Wide-field fundus photograph of an infant. Phoenix ICON, 100° FOV — 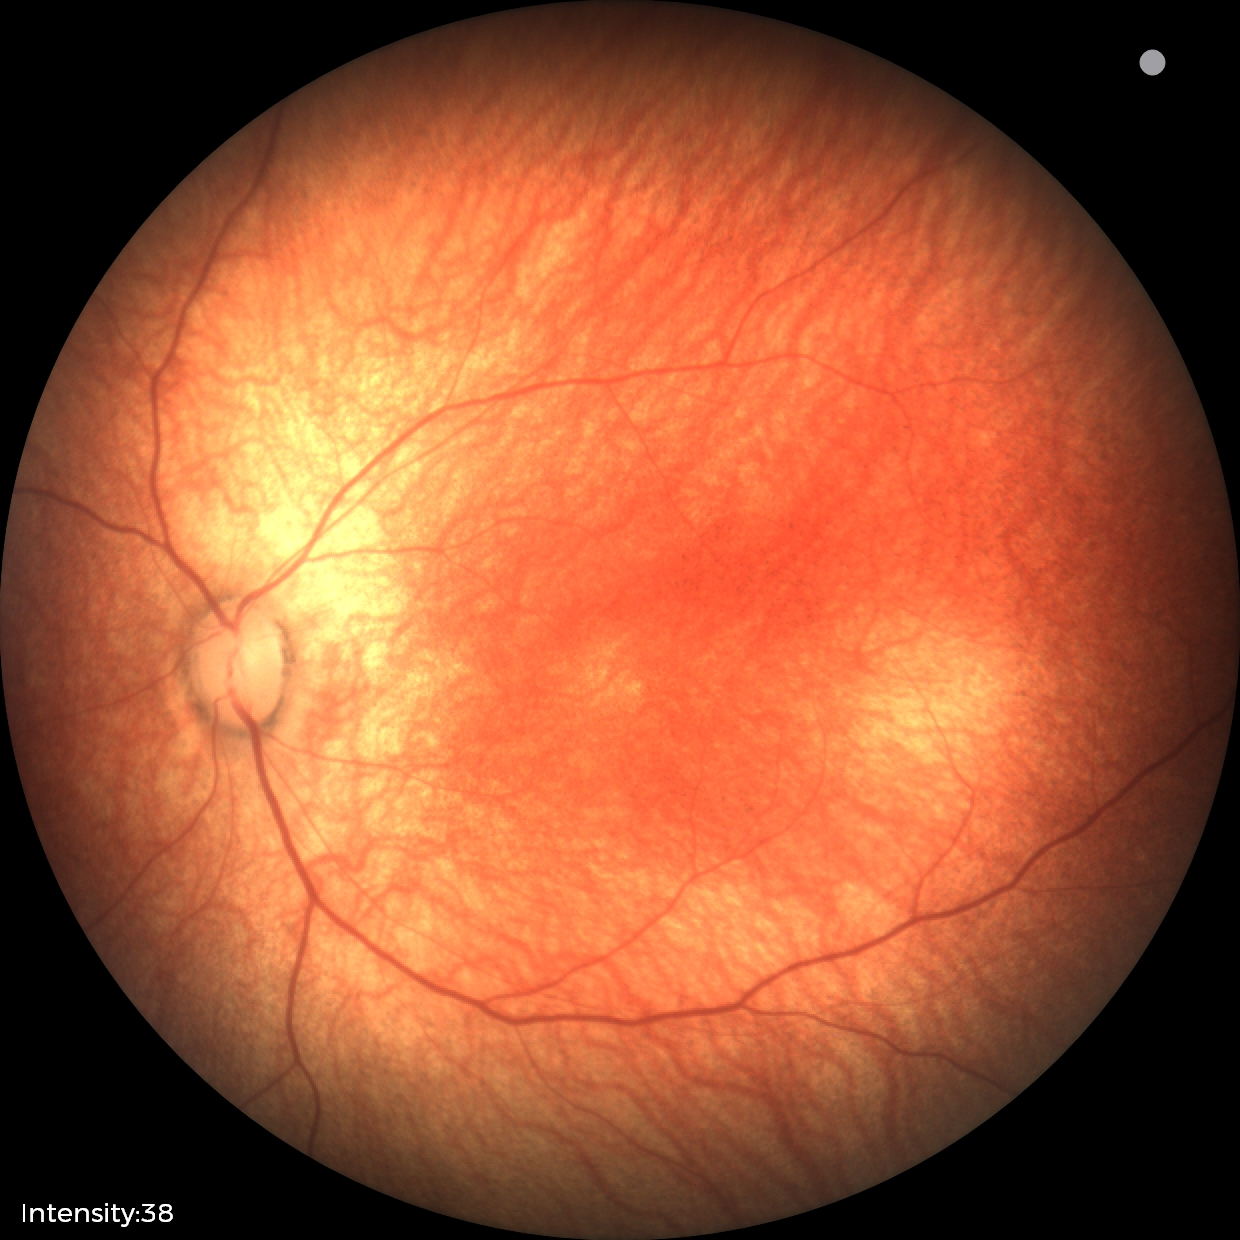

Impression: physiological.